50-degree field of view; retinal fundus photograph; 2228 by 1652 pixels; posterior pole view; dilated-pupil acquisition; Topcon TRC-50DX: 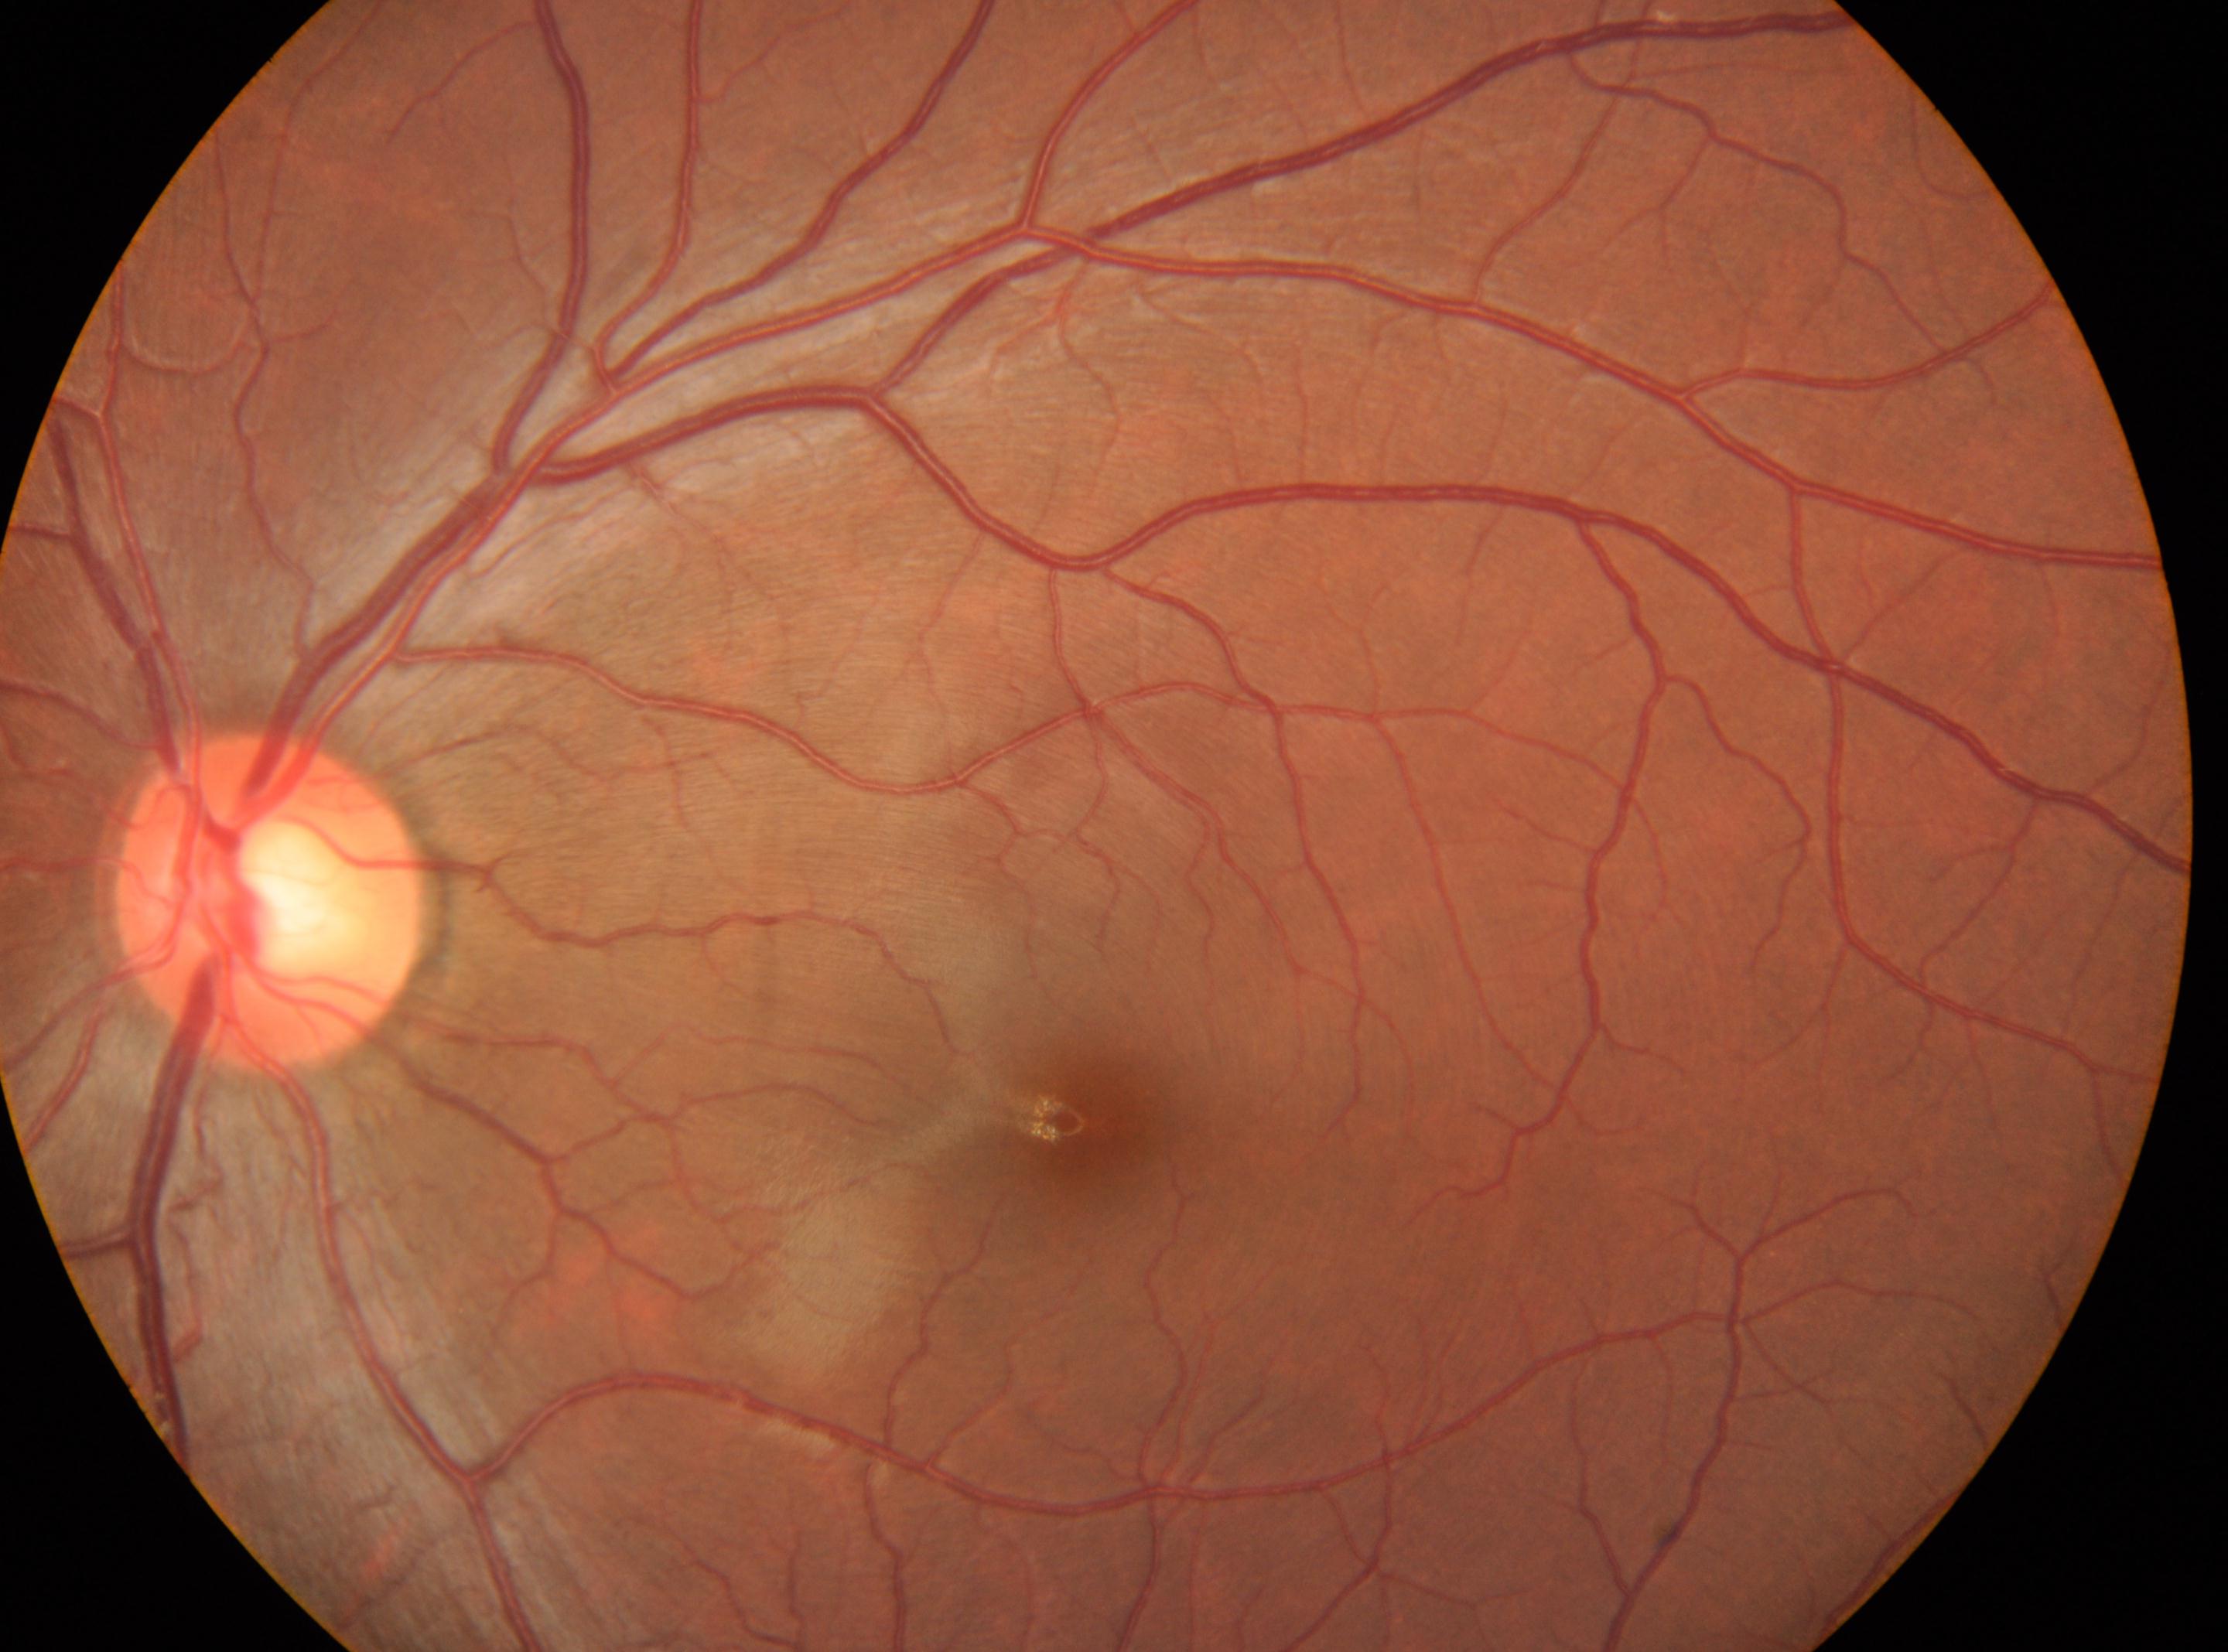

laterality = left eye; fovea center = (1091,1121); retinopathy = no apparent retinopathy (grade 0); the optic disc = (269,903).